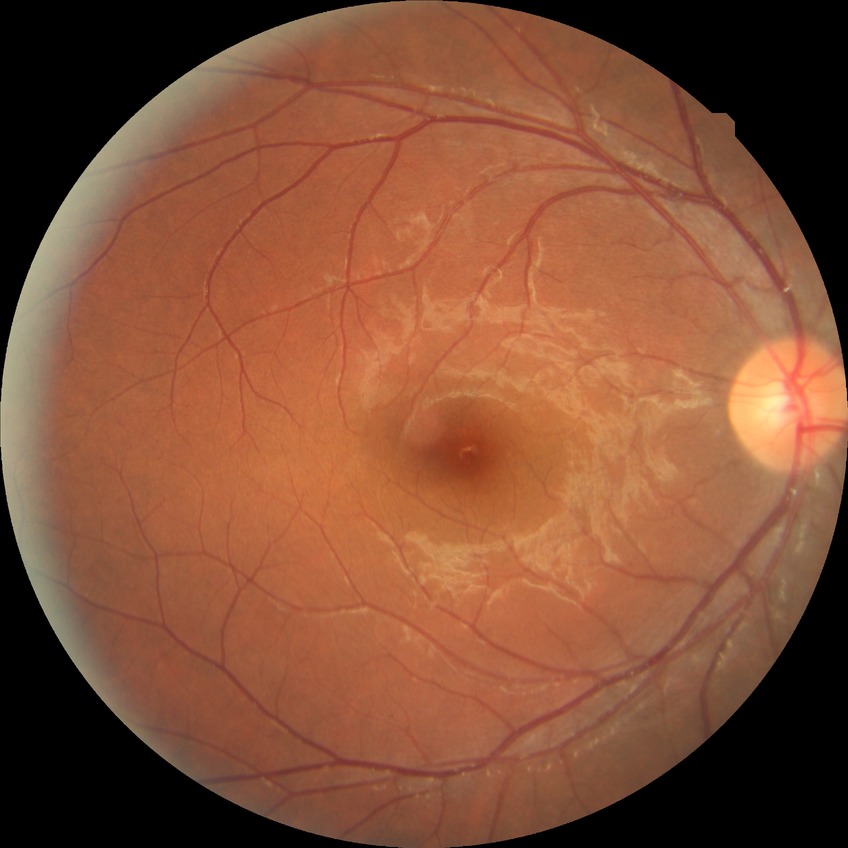

Assessment:
* diabetic retinopathy (DR) — no diabetic retinopathy (NDR)